2212x1659px; retinal fundus photograph — 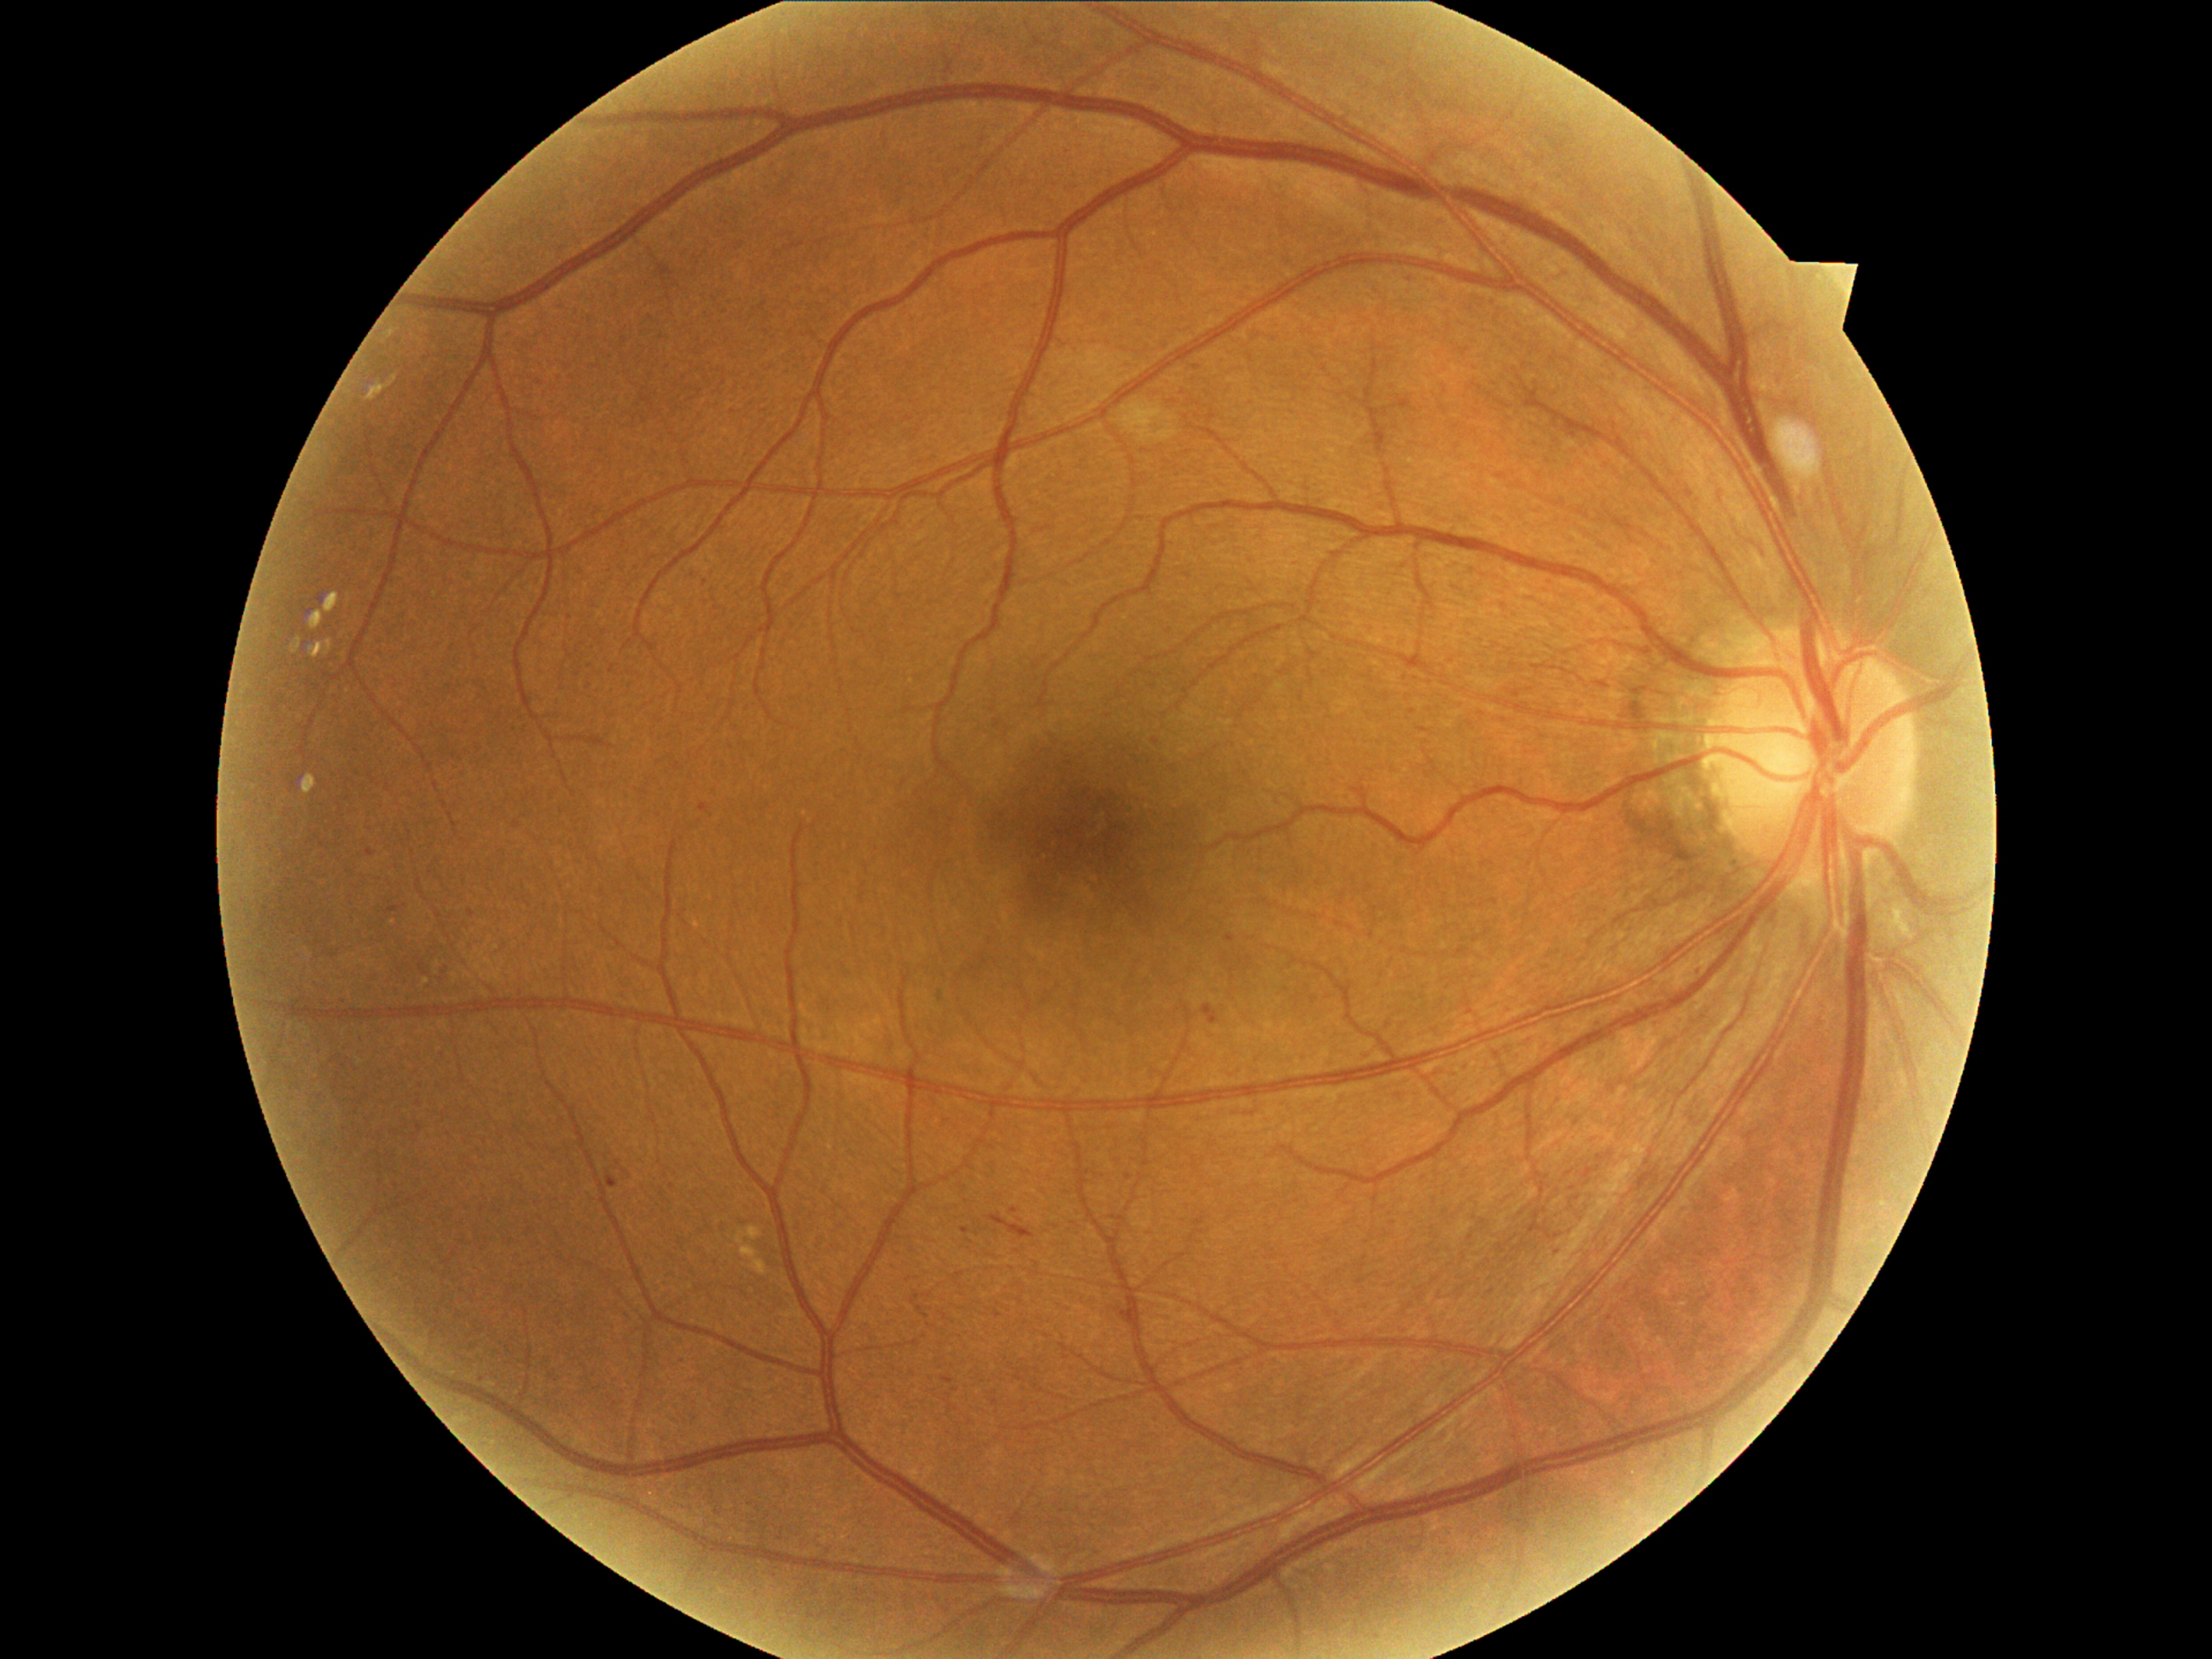
Diabetic retinopathy (DR) is 2/4
Selected lesions:
soft exudates (SEs): <bbox>1122, 402, 1179, 443</bbox>
hard exudates (EXs): not present
hemorrhages (HEs): <bbox>989, 1214, 1035, 1238</bbox>
microaneurysms (MAs) (more not shown): <bbox>962, 1228, 970, 1235</bbox>, <bbox>943, 1377, 955, 1385</bbox>, <bbox>1226, 936, 1237, 943</bbox>, <bbox>1010, 1209, 1018, 1214</bbox>, <bbox>607, 1172, 619, 1189</bbox>, <bbox>368, 849, 376, 858</bbox>, <bbox>1484, 861, 1493, 868</bbox>, <bbox>1202, 1004, 1220, 1027</bbox>, <bbox>701, 803, 709, 813</bbox>
MAs (small, approximate centers) near [1156, 741], [998, 1315], [1198, 368], [1555, 1253]